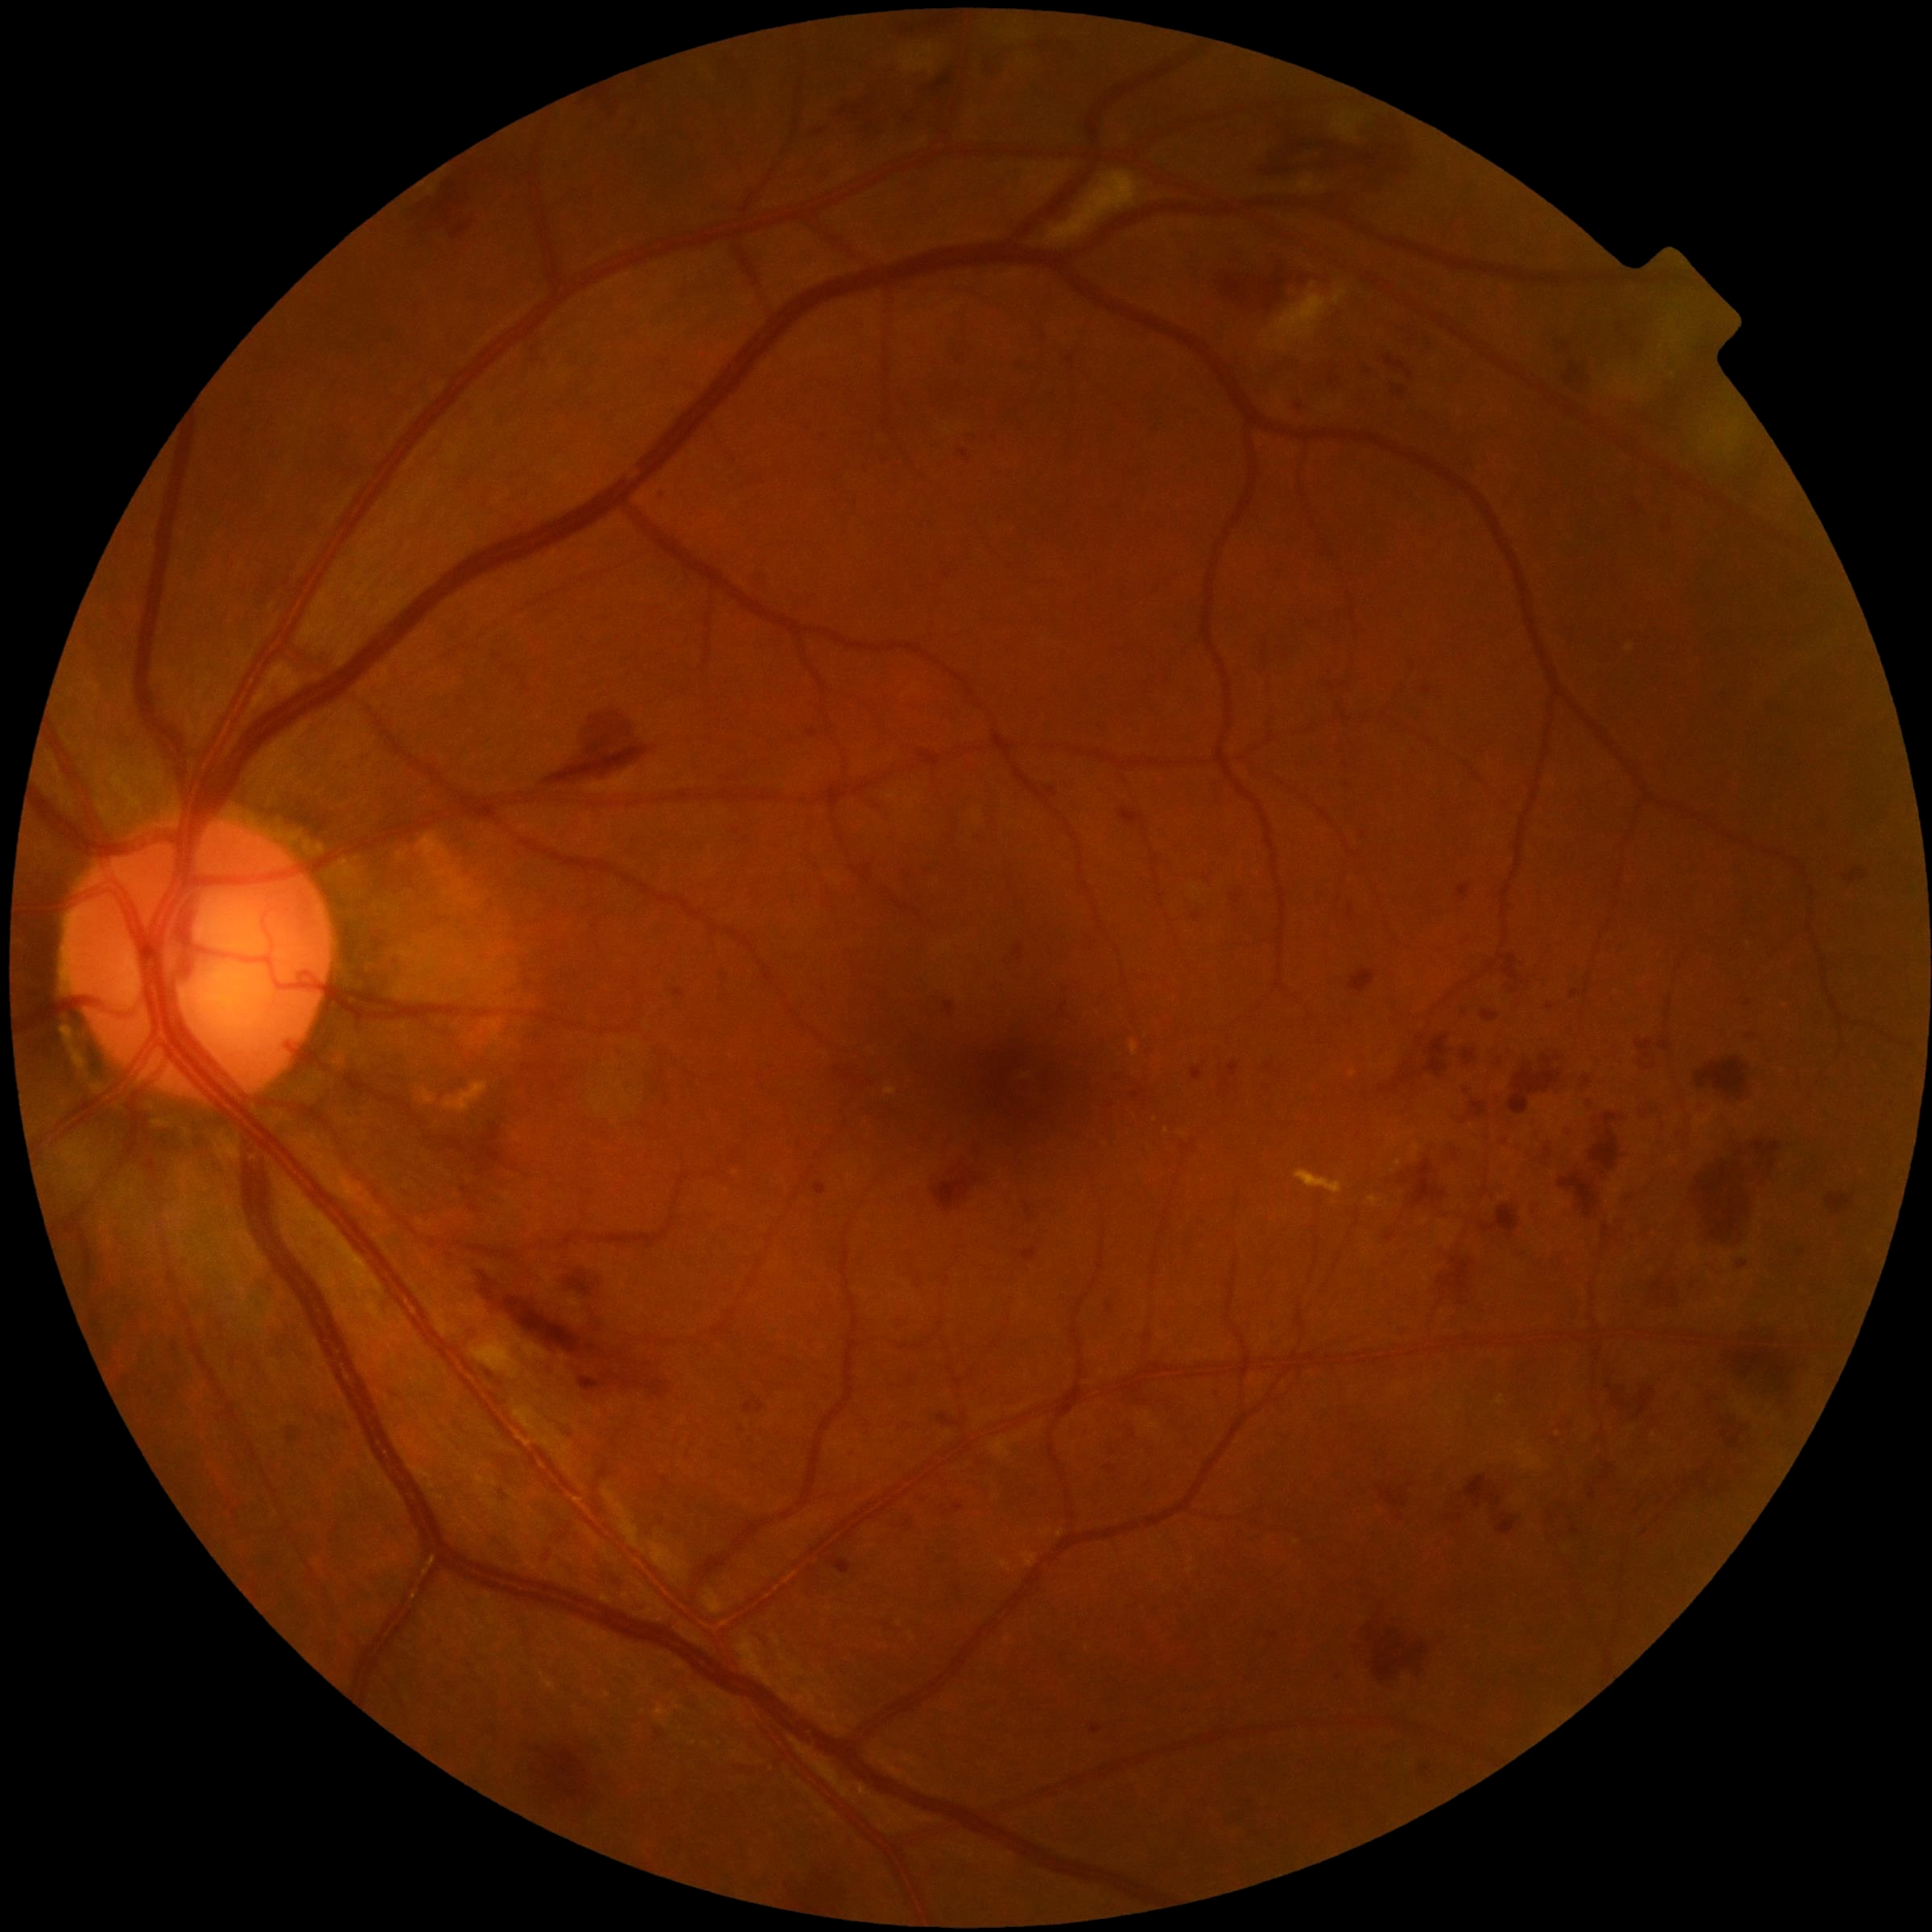

DR stage: moderate non-proliferative diabetic retinopathy (grade 2) — more than just microaneurysms but less than severe NPDR.